1240 by 1240 pixels · acquired on the Phoenix ICON · infant wide-field fundus photograph.
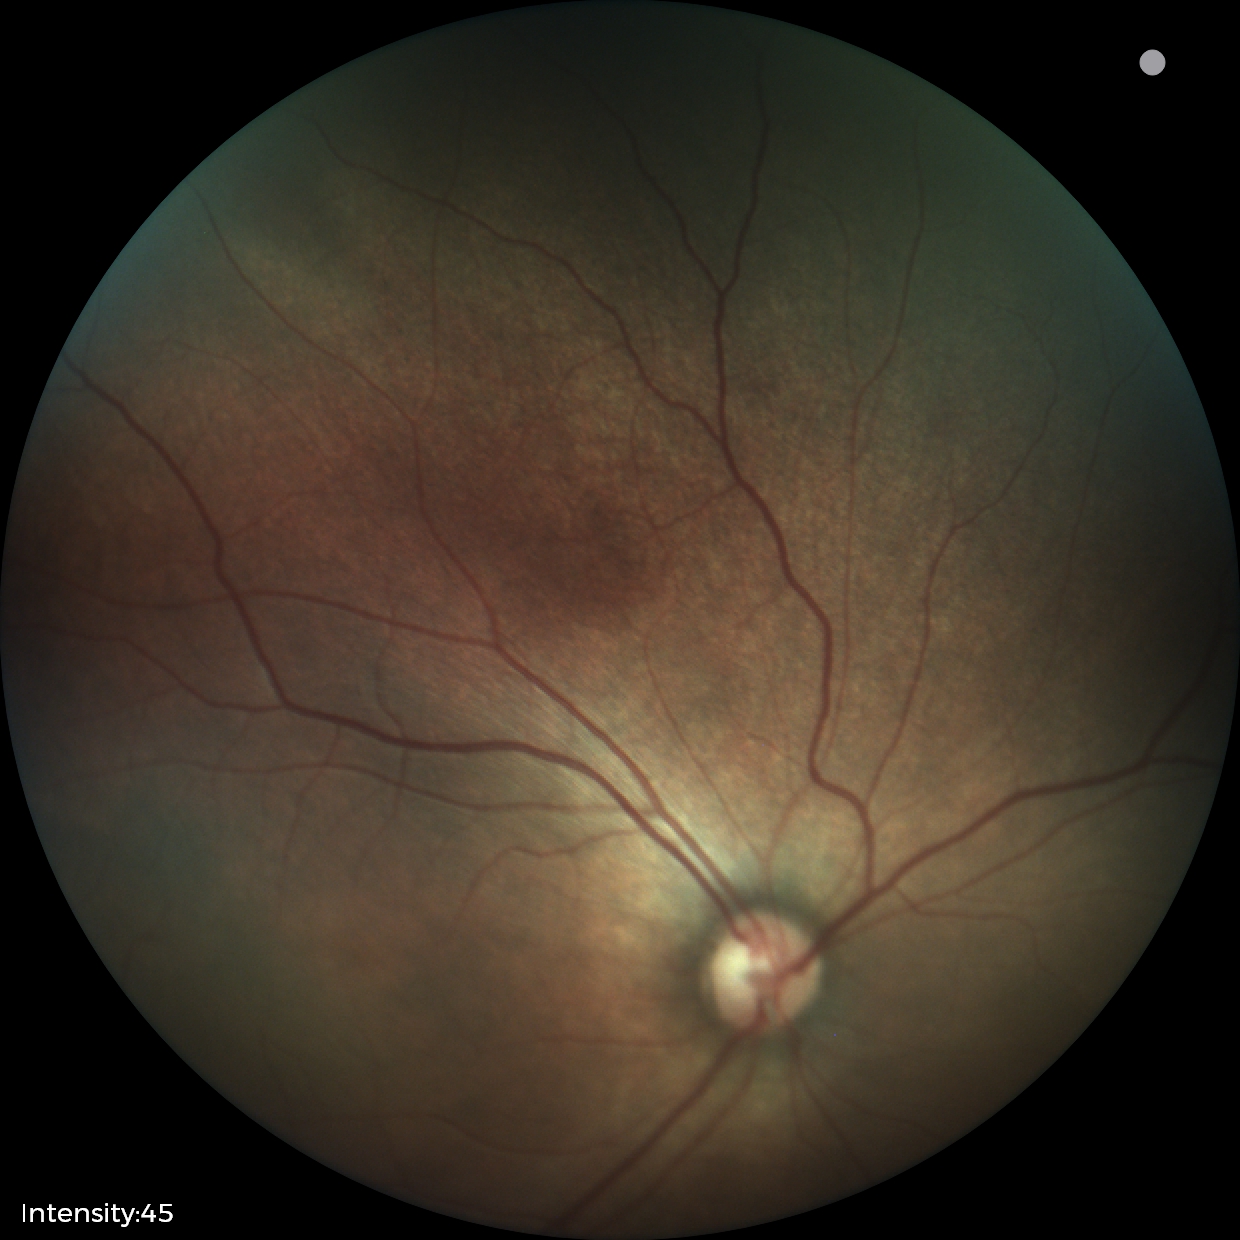
Screening series with status post retinopathy of prematurity. Plus disease absent.